1240x1240px; wide-field fundus photograph of an infant
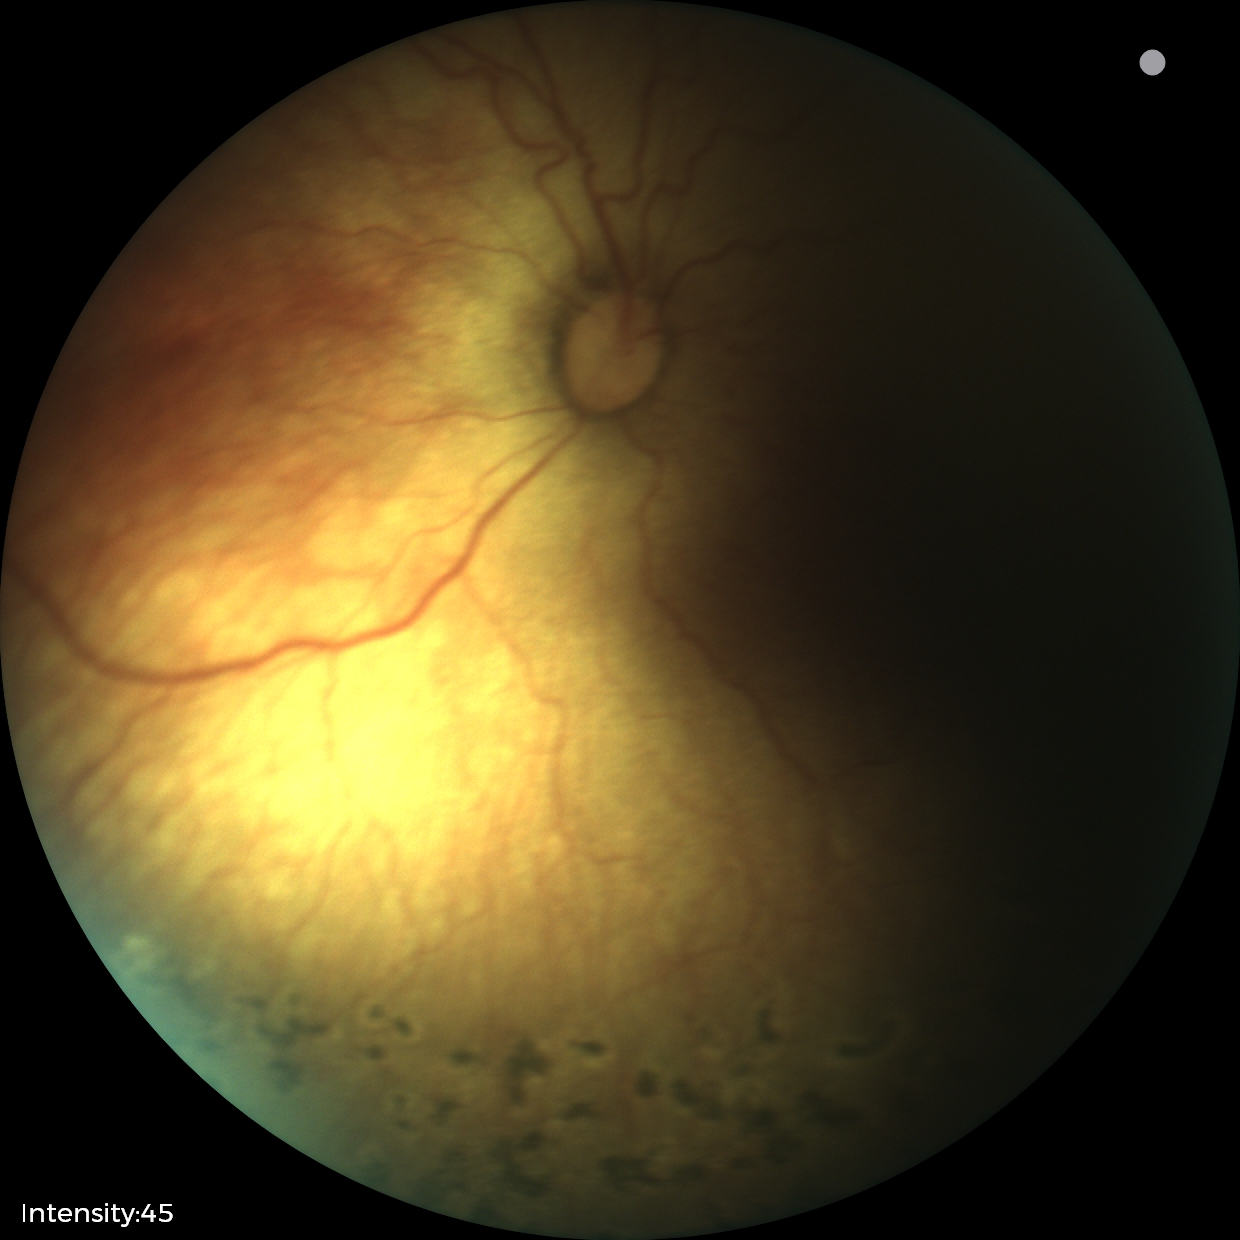
From an examination with diagnosis of status post retinopathy of prematurity (ROP) — retinal appearance after treated retinopathy of prematurity.
Without plus disease.